Color fundus photograph. Without pupil dilation. NIDEK AFC-230.
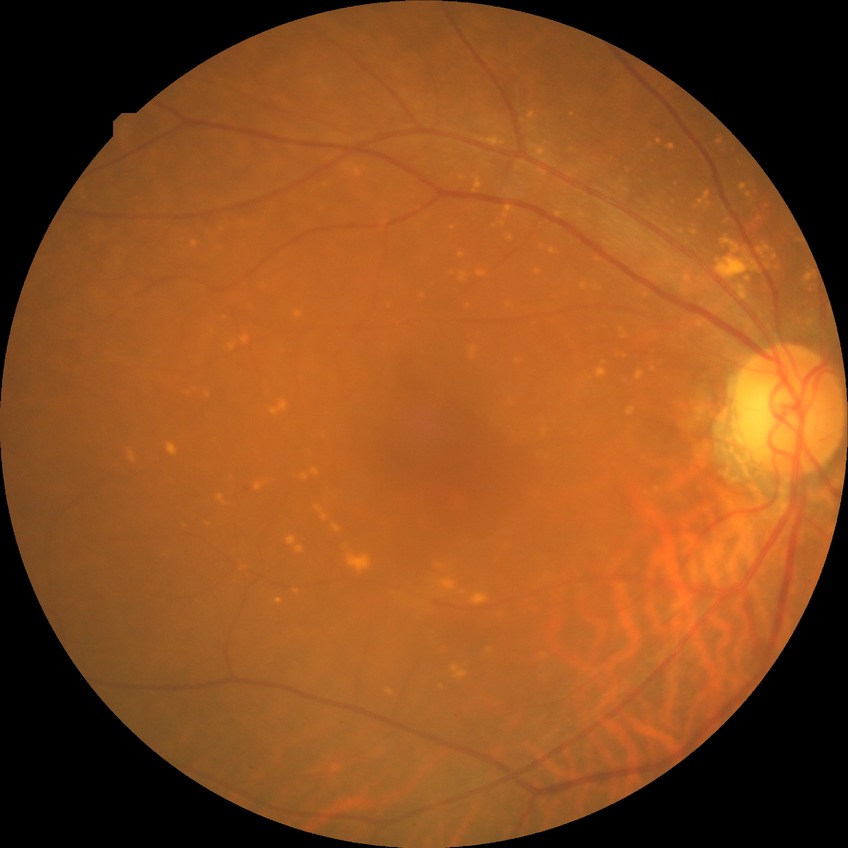 DR stage@SDR.